Retinal fundus photograph
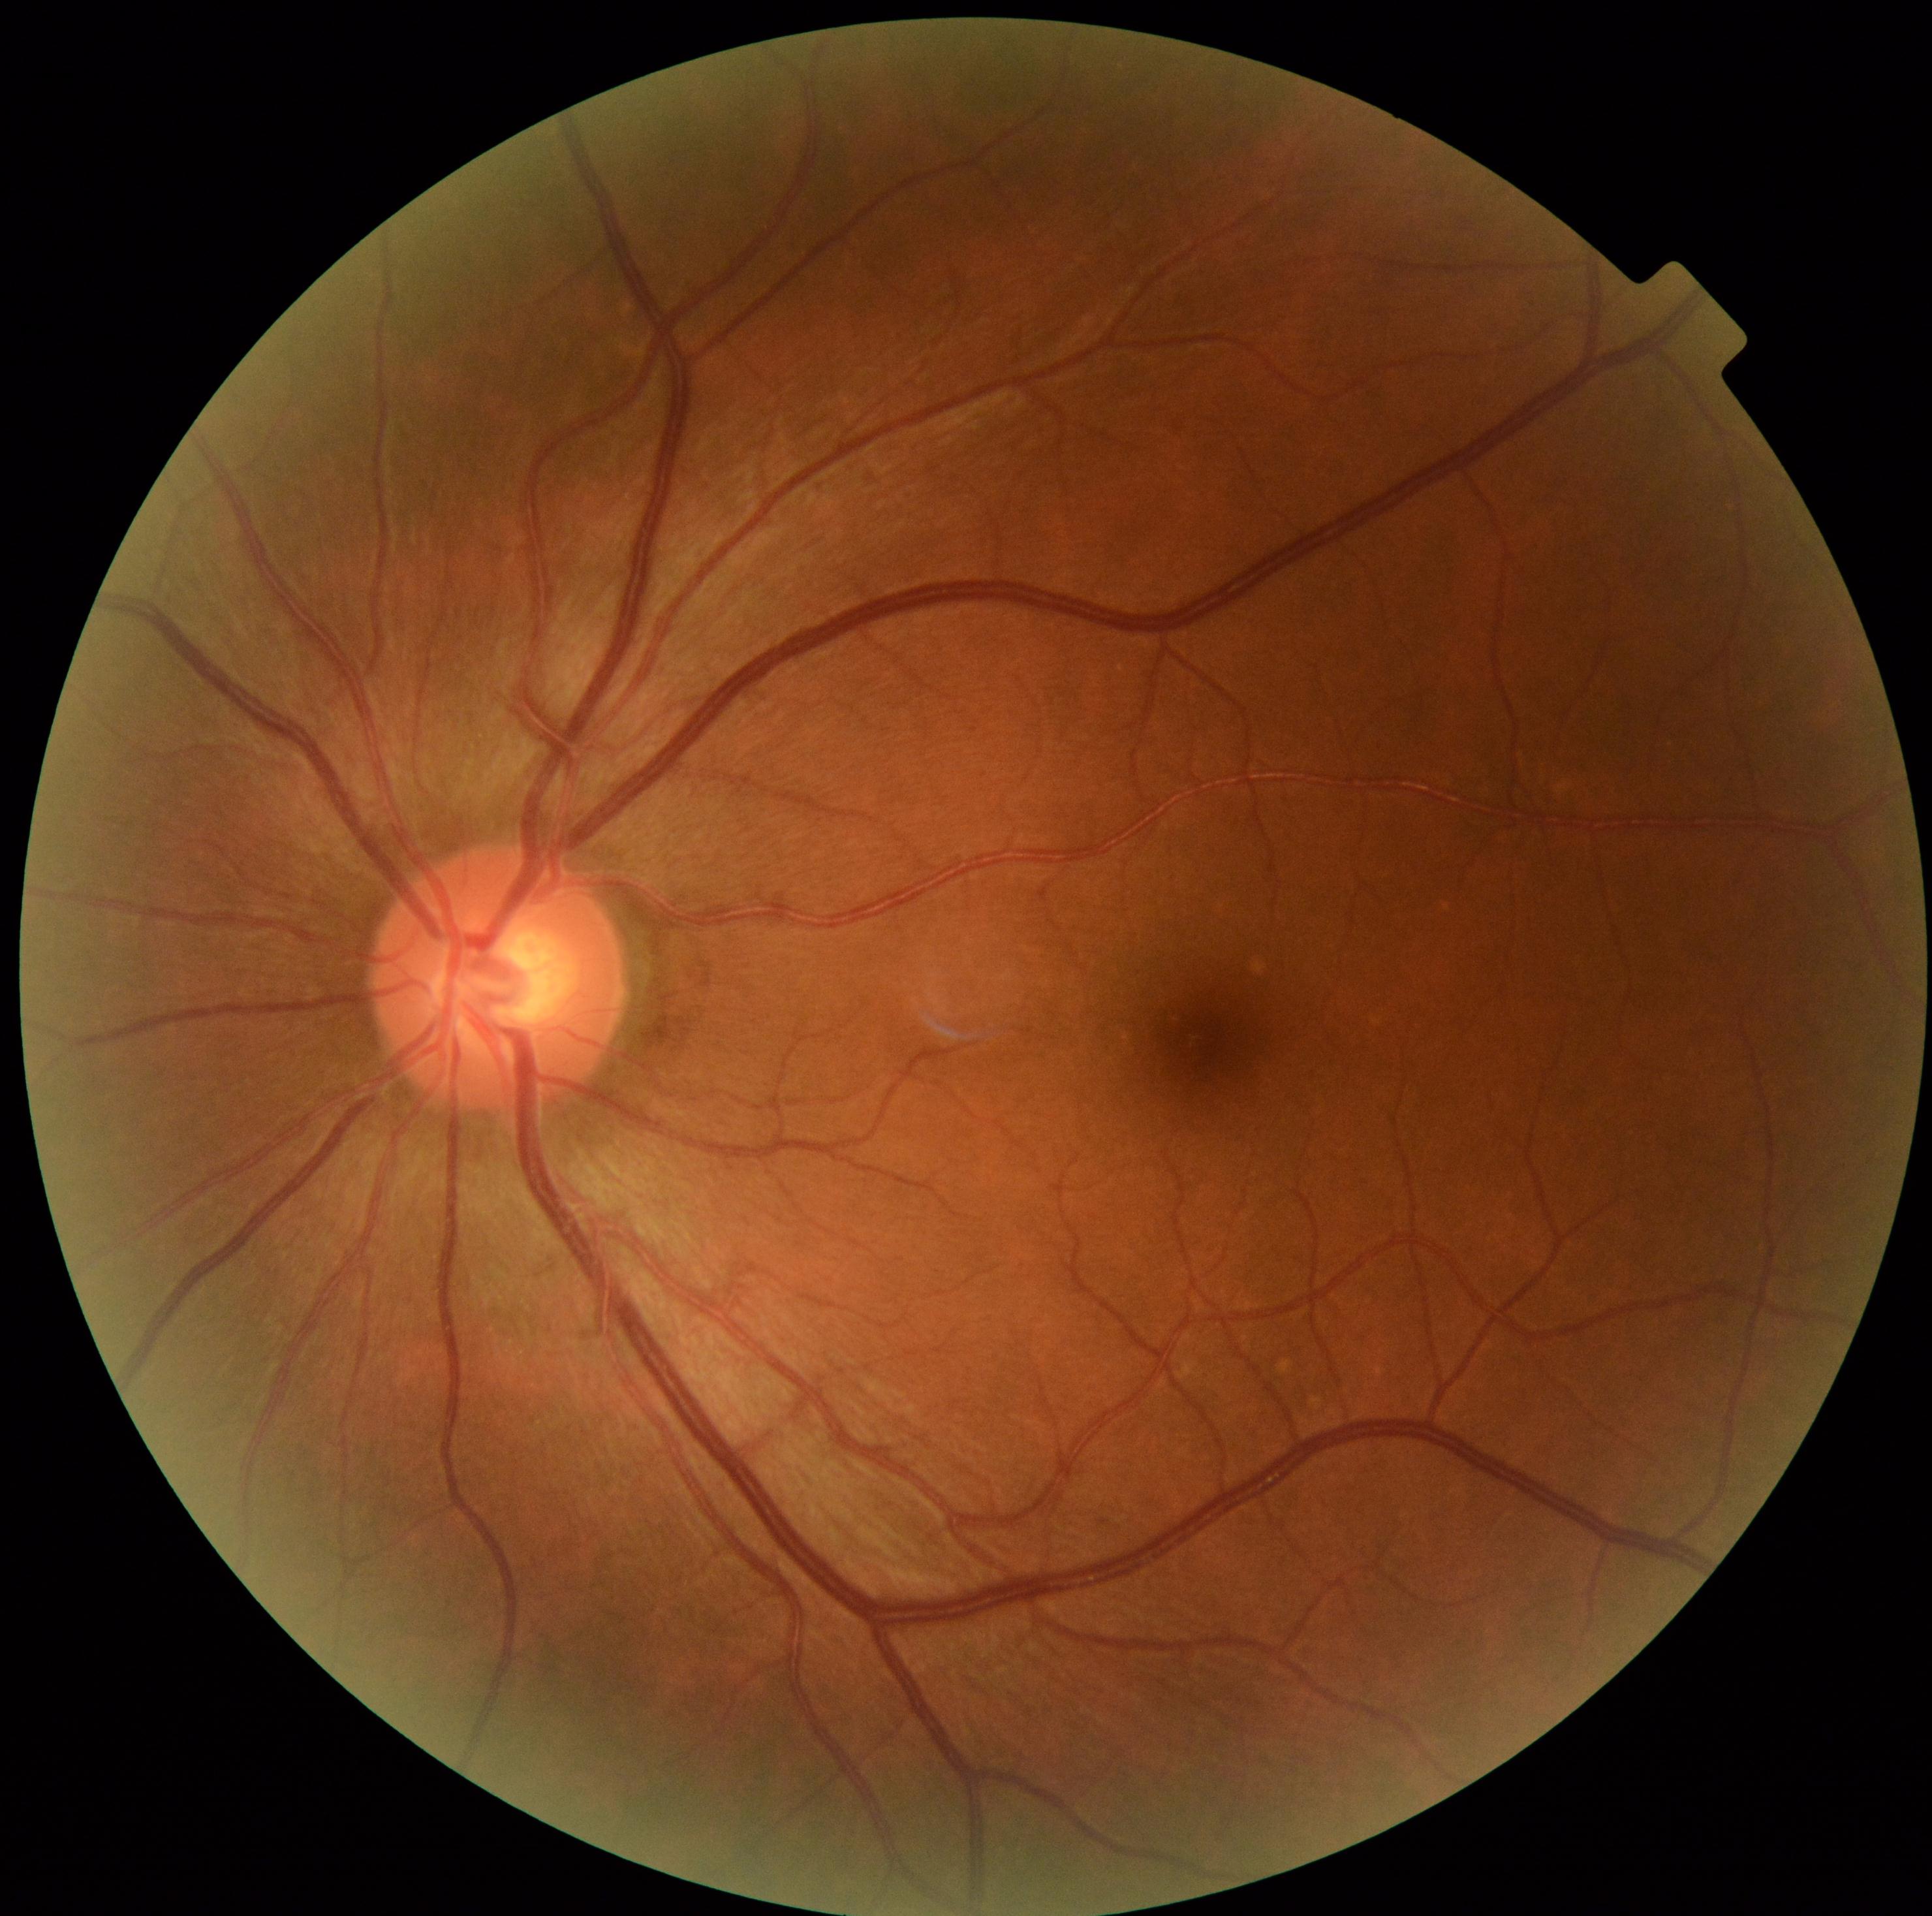 {
  "dr_impression": "negative for DR",
  "dr_grade": "no apparent retinopathy (0)"
}